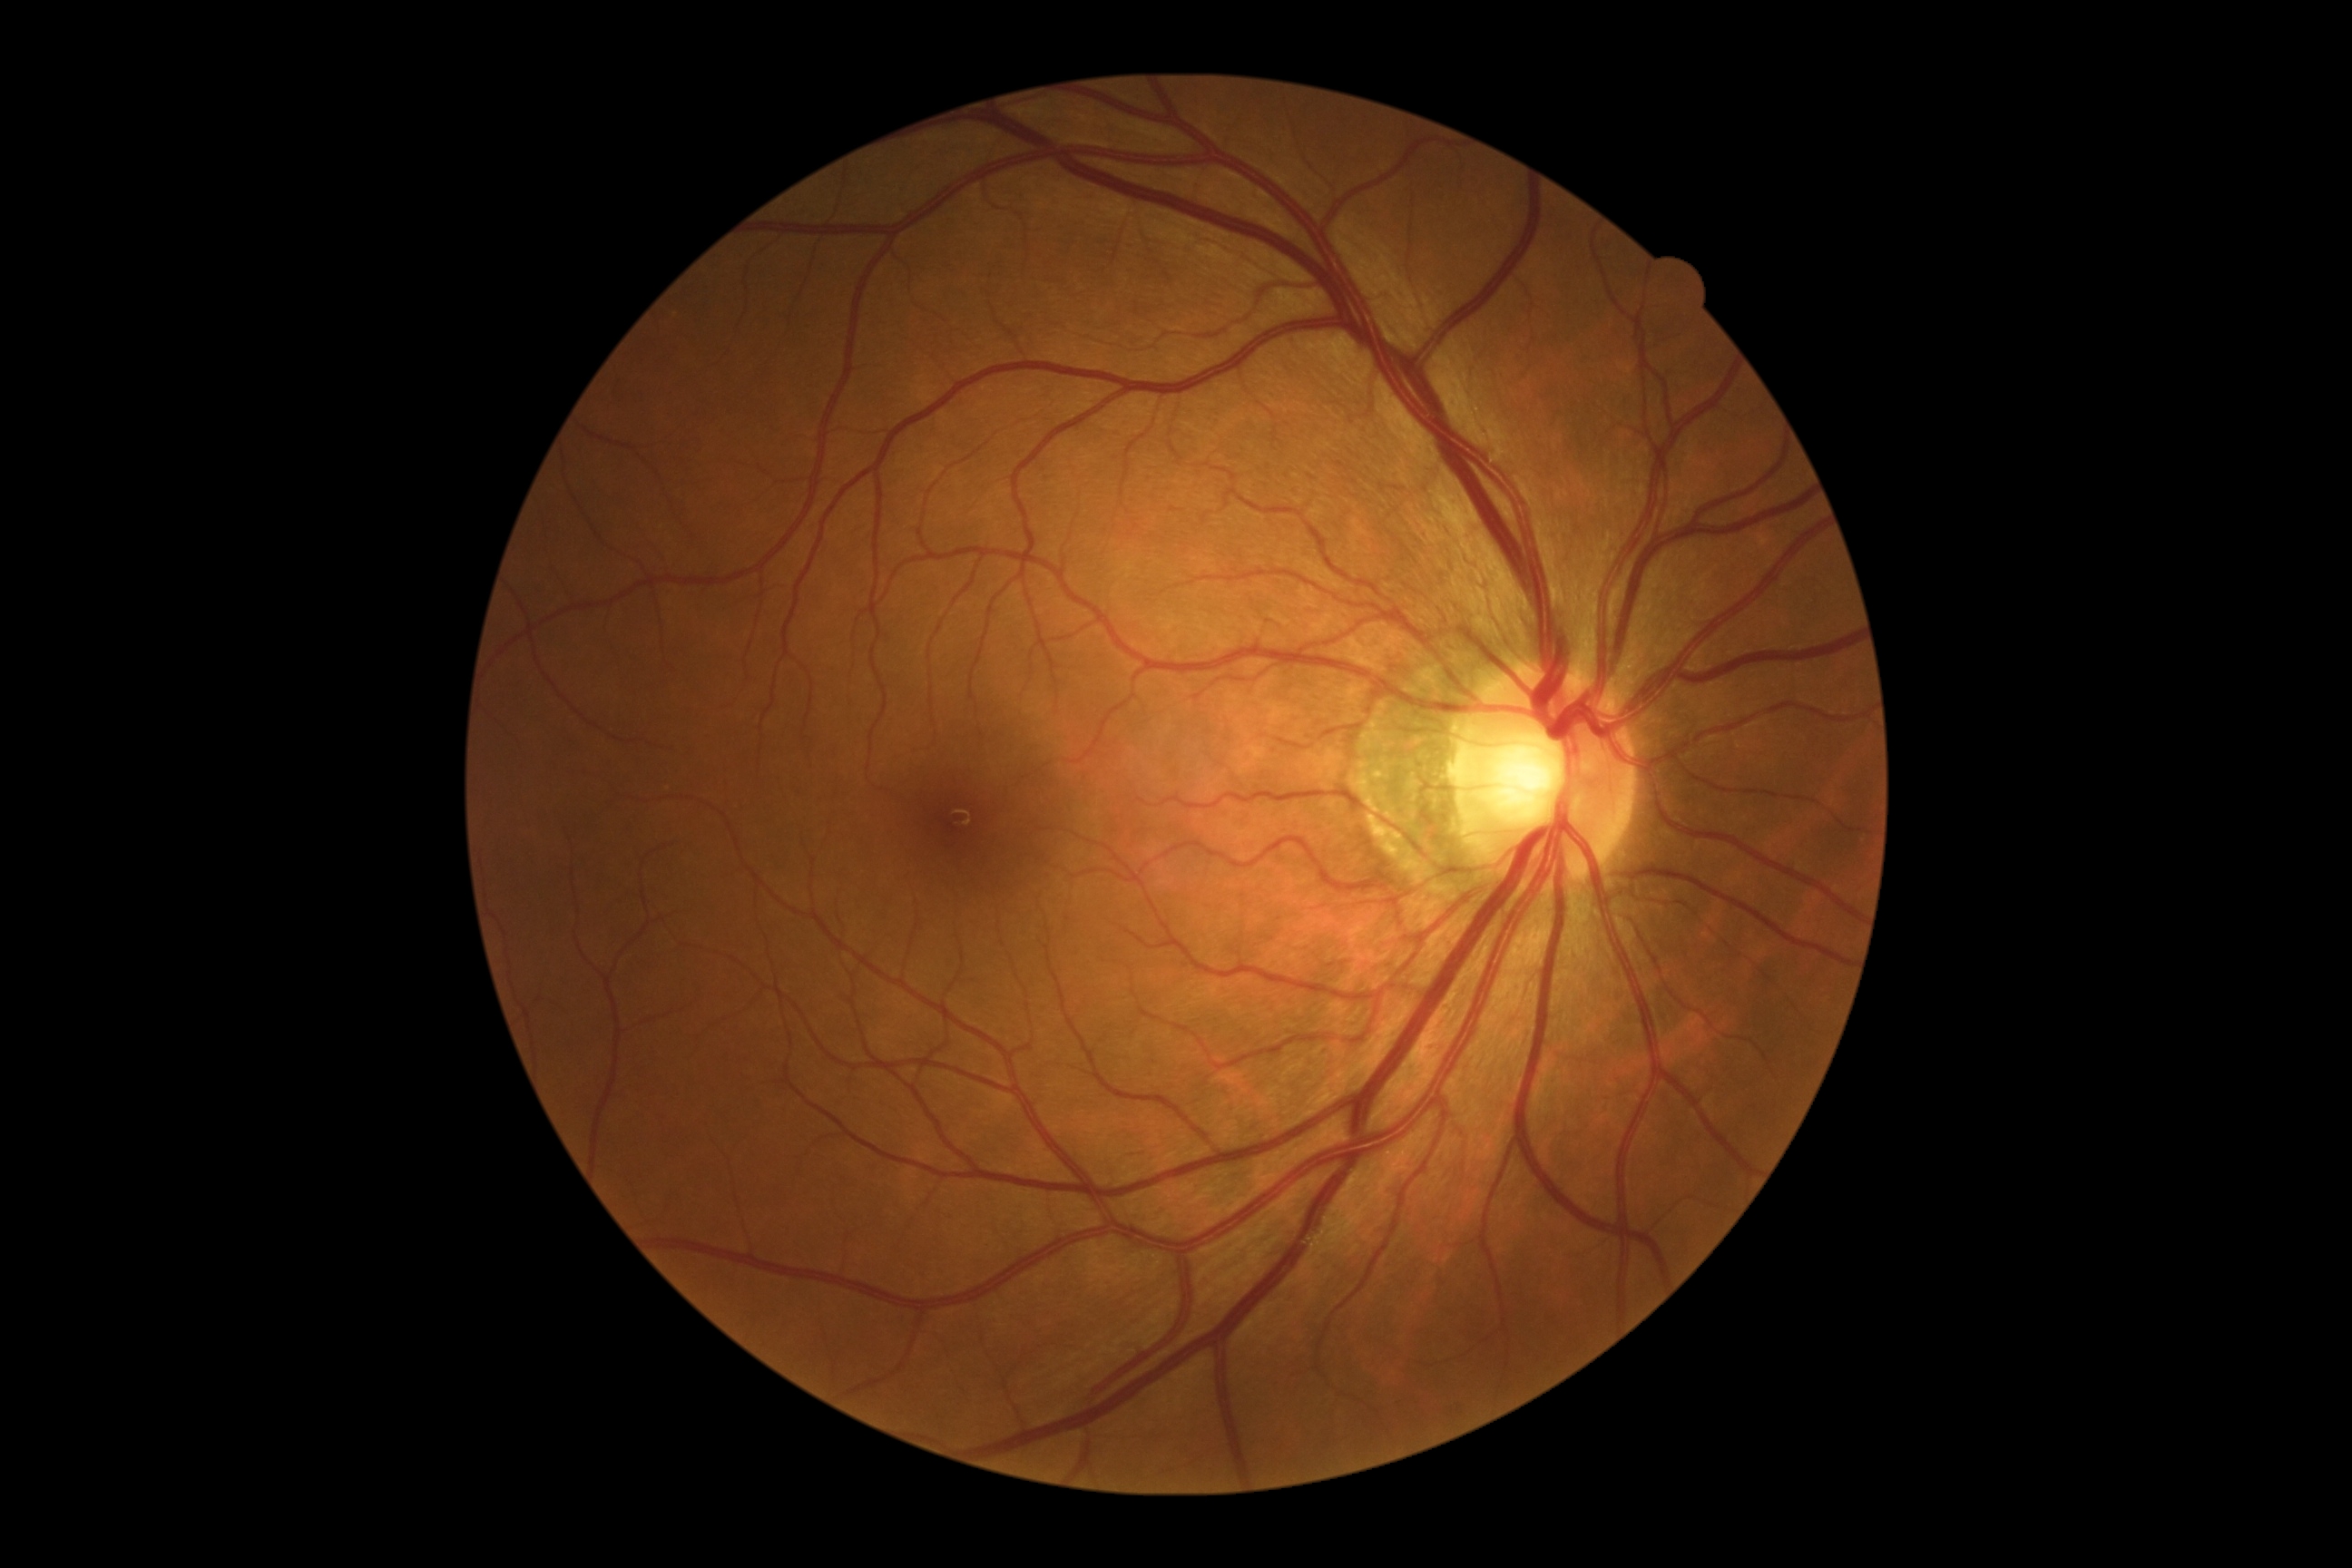

Diabetic retinopathy grade is 0 (no apparent retinopathy).